CFP, FOV: 45 degrees:
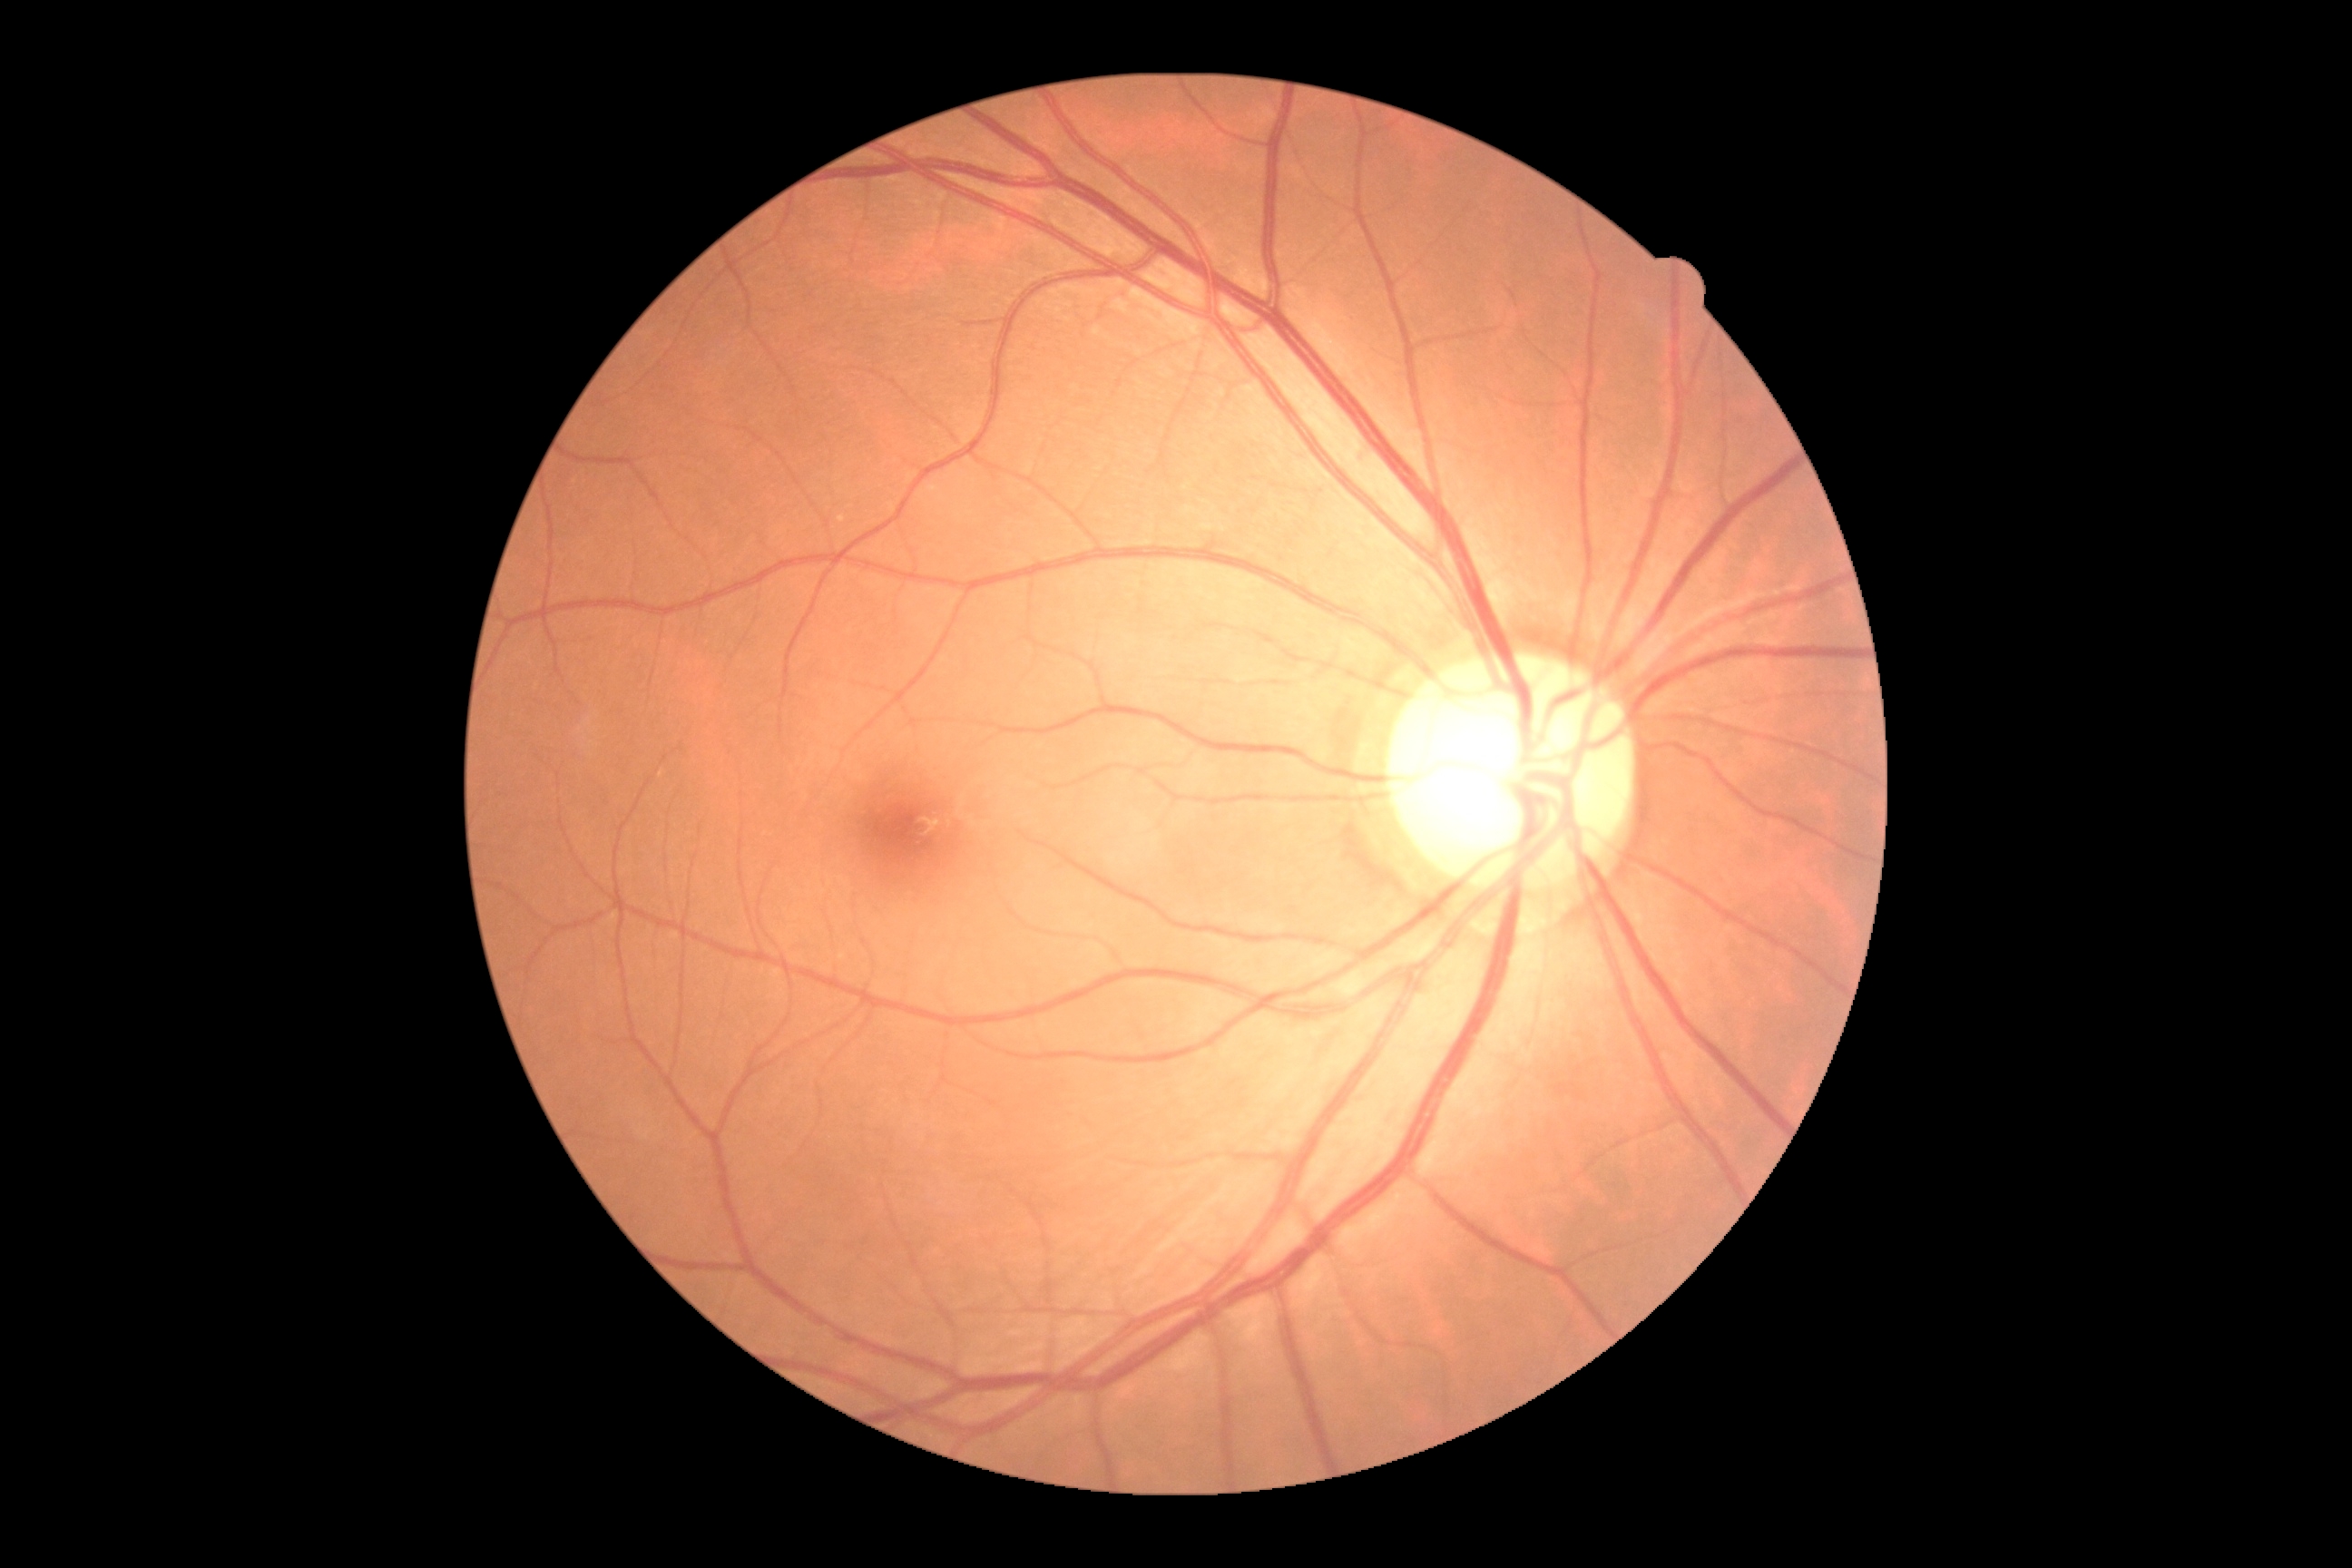

{"dr_grade": "no apparent retinopathy (grade 0)"}